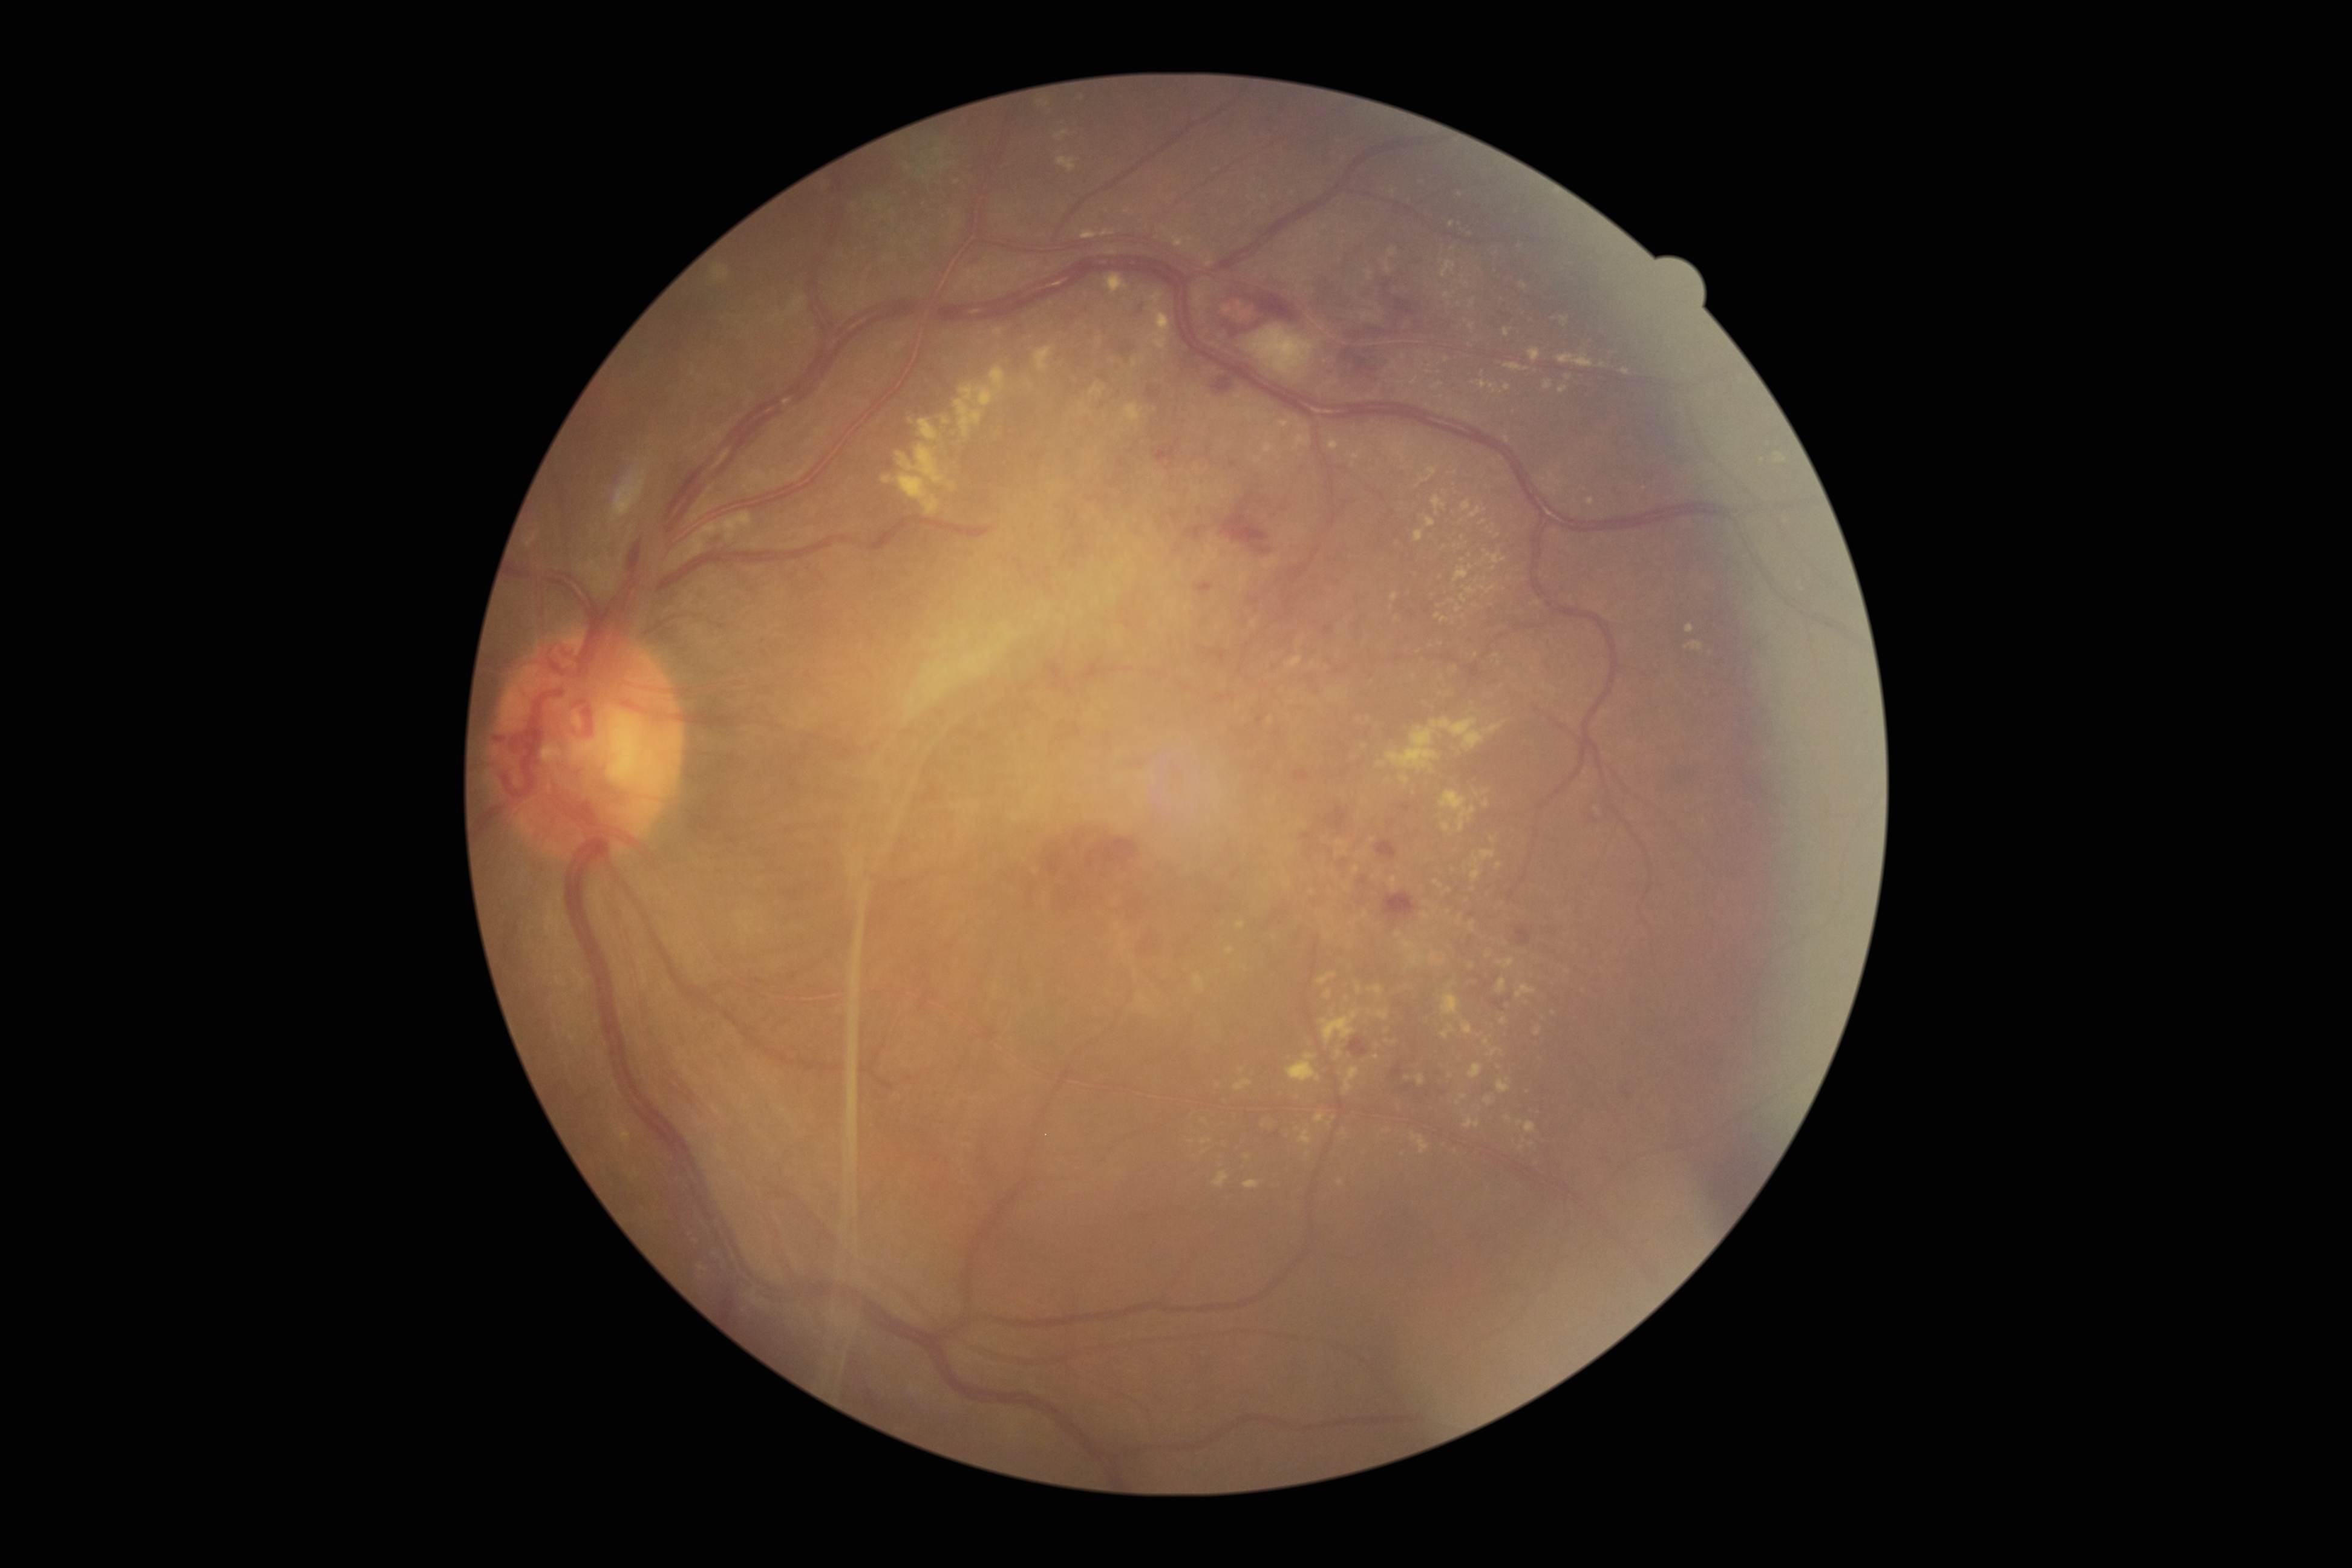

DR: grade 4.
EXs include those at x1=1329, y1=440, x2=1339, y2=451, x1=616, y1=1129, x2=629, y2=1135, x1=1336, y1=840, x2=1345, y2=848, x1=954, y1=366, x2=1006, y2=437, x1=1299, y1=1129, x2=1312, y2=1145, x1=1497, y1=1080, x2=1511, y2=1093, x1=1431, y1=382, x2=1443, y2=389, x1=1411, y1=378, x2=1419, y2=385, x1=1432, y1=497, x2=1446, y2=515, x1=1056, y1=131, x2=1070, y2=141, x1=1357, y1=987, x2=1361, y2=995, x1=1504, y1=1116, x2=1512, y2=1122, x1=1411, y1=1132, x2=1429, y2=1155.
Small EXs approximately at [x=1441, y=679], [x=1523, y=286], [x=1365, y=799], [x=1452, y=601], [x=1356, y=870], [x=1473, y=889], [x=1247, y=1156].